Phoenix ICON wide-field infant fundus image. 1240x1240: 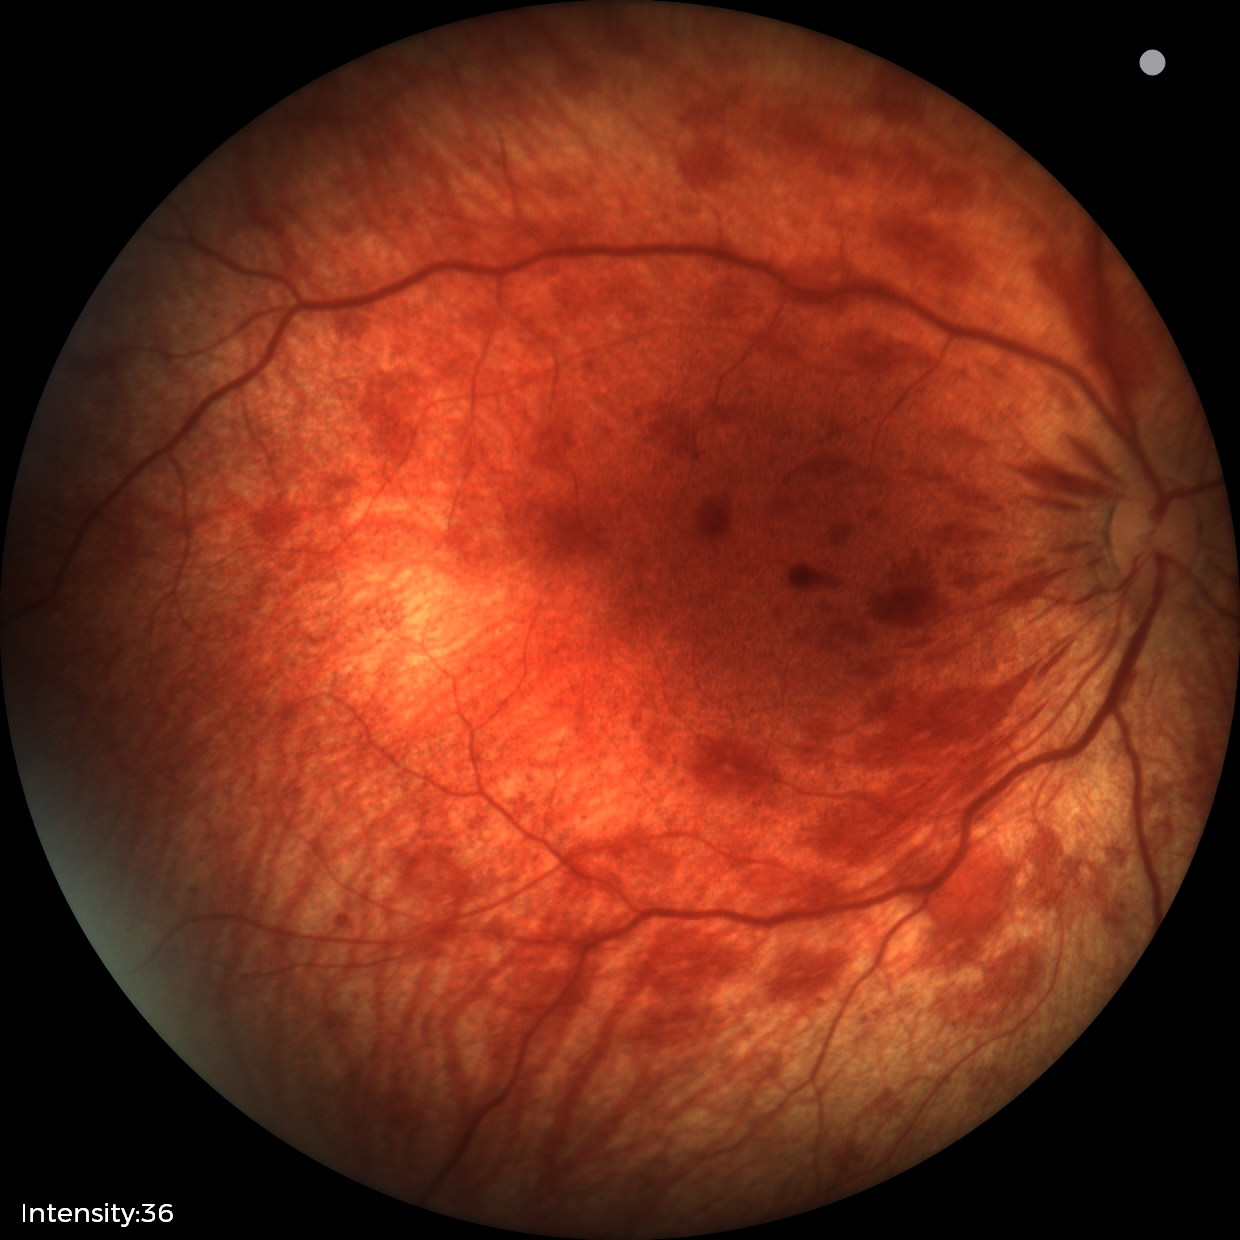

Series diagnosed as retinal hemorrhages.